Color fundus image:
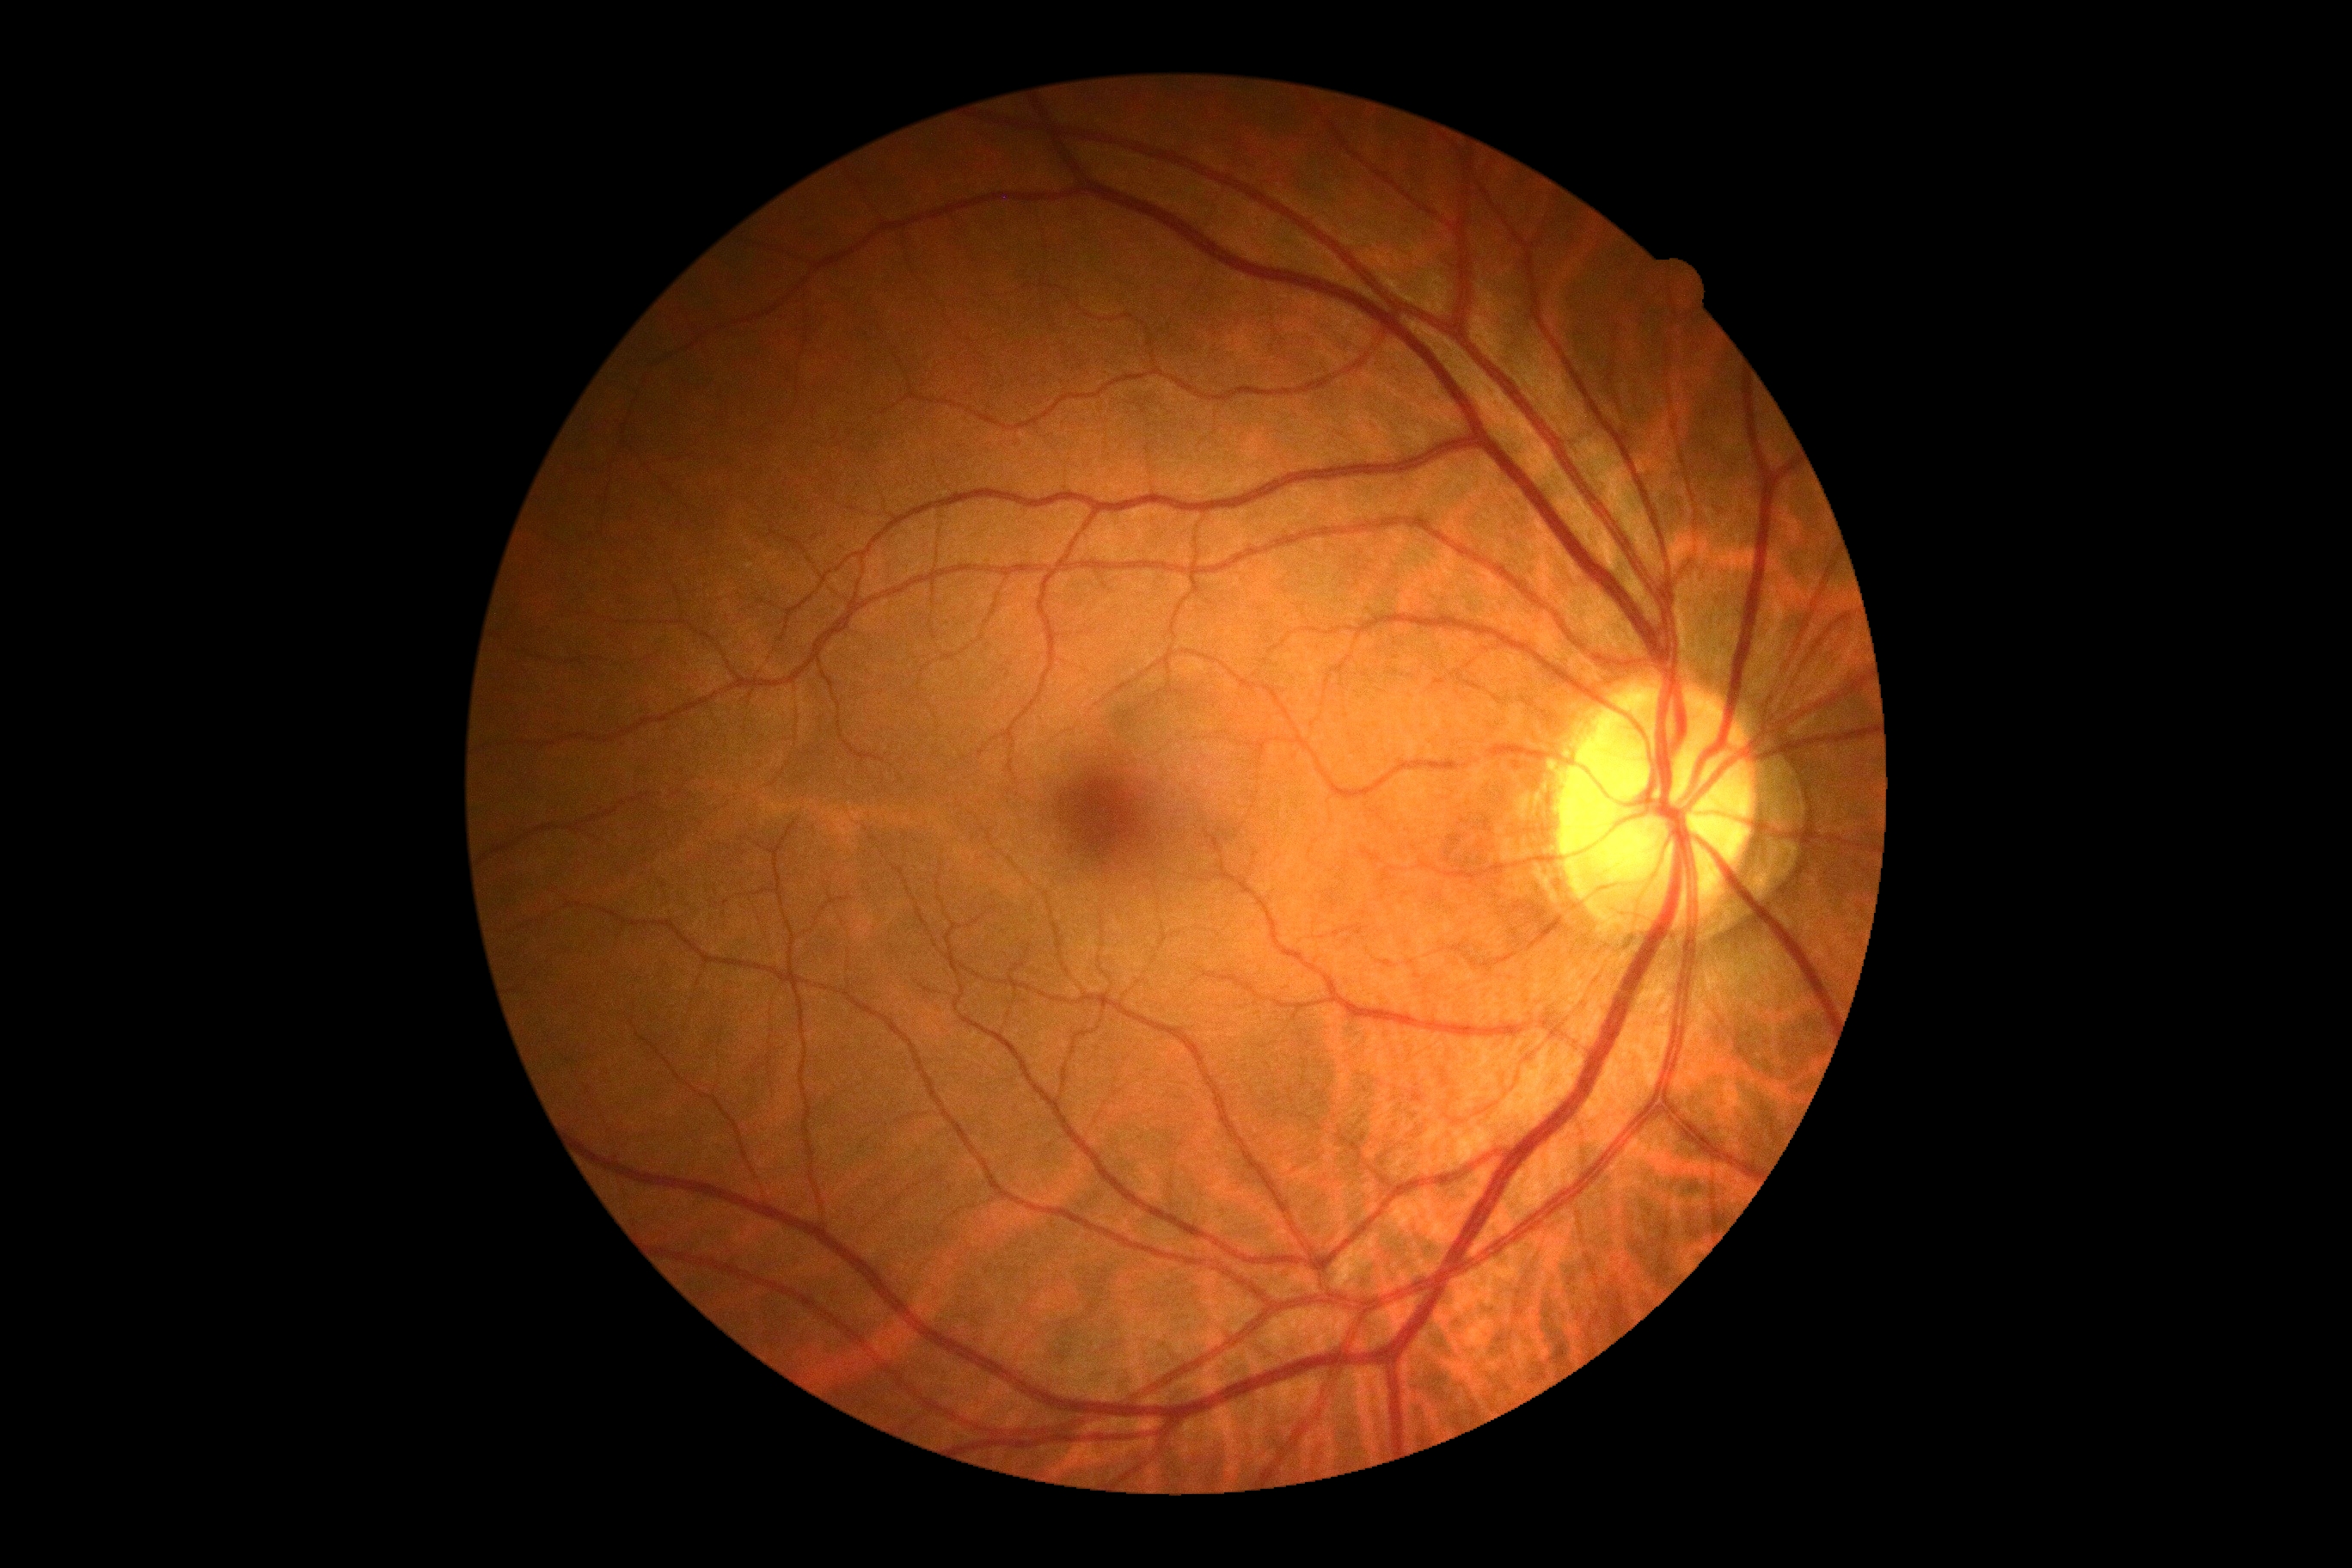
DR severity: 0.